45° field of view. 1725 x 1721 pixels.
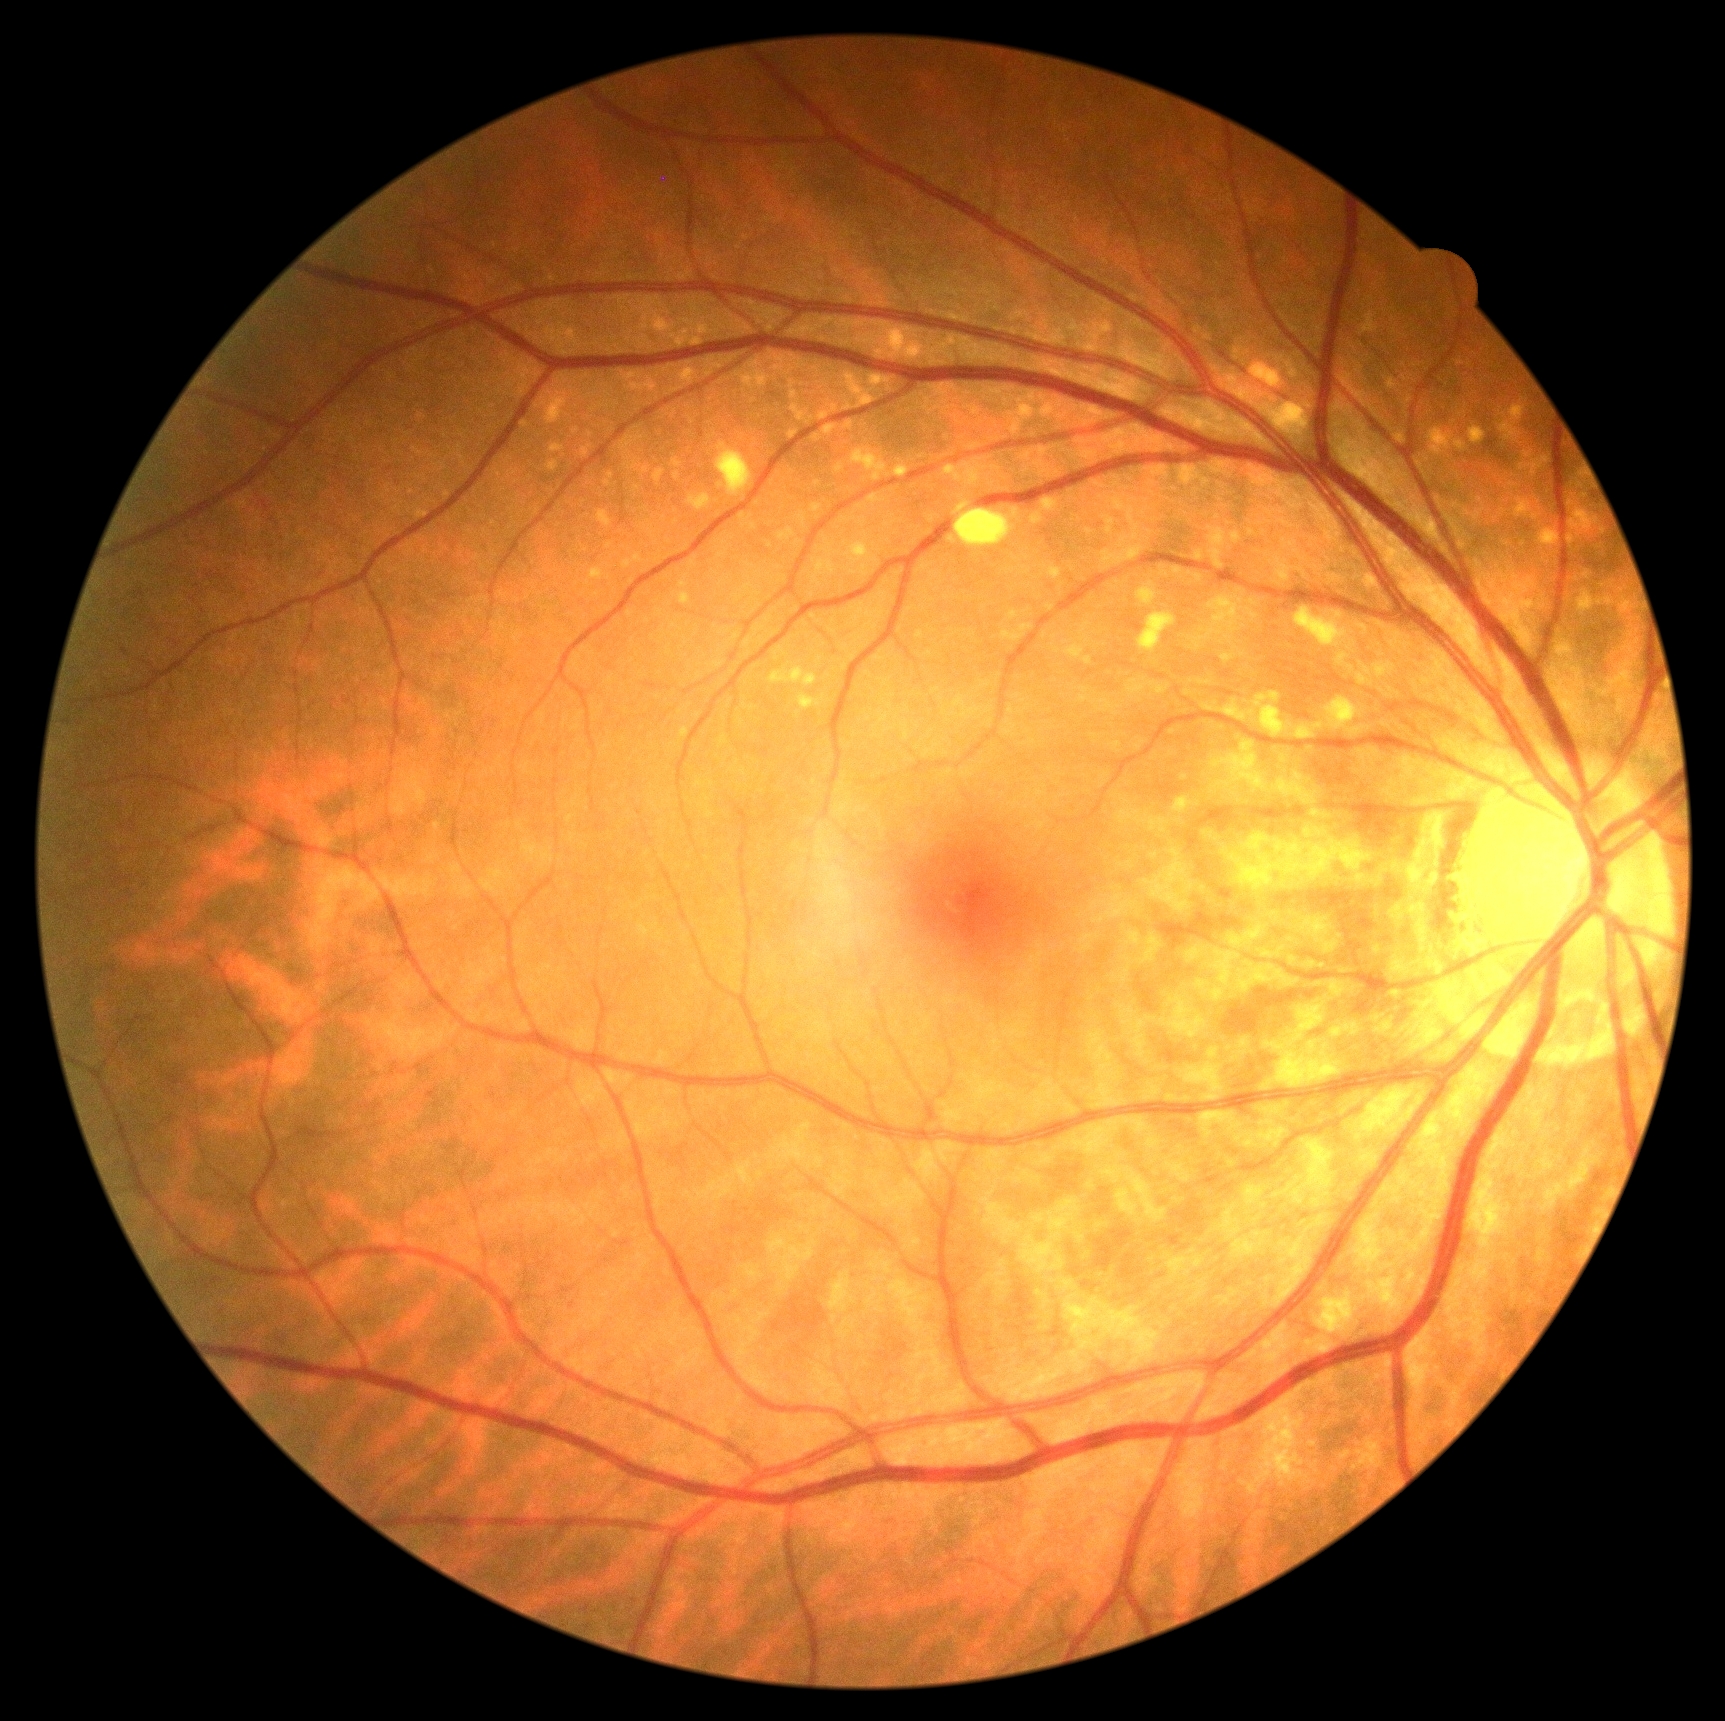   dr_grade: no apparent diabetic retinopathy (grade 0)